Camera: Remidio Fundus on Phone: 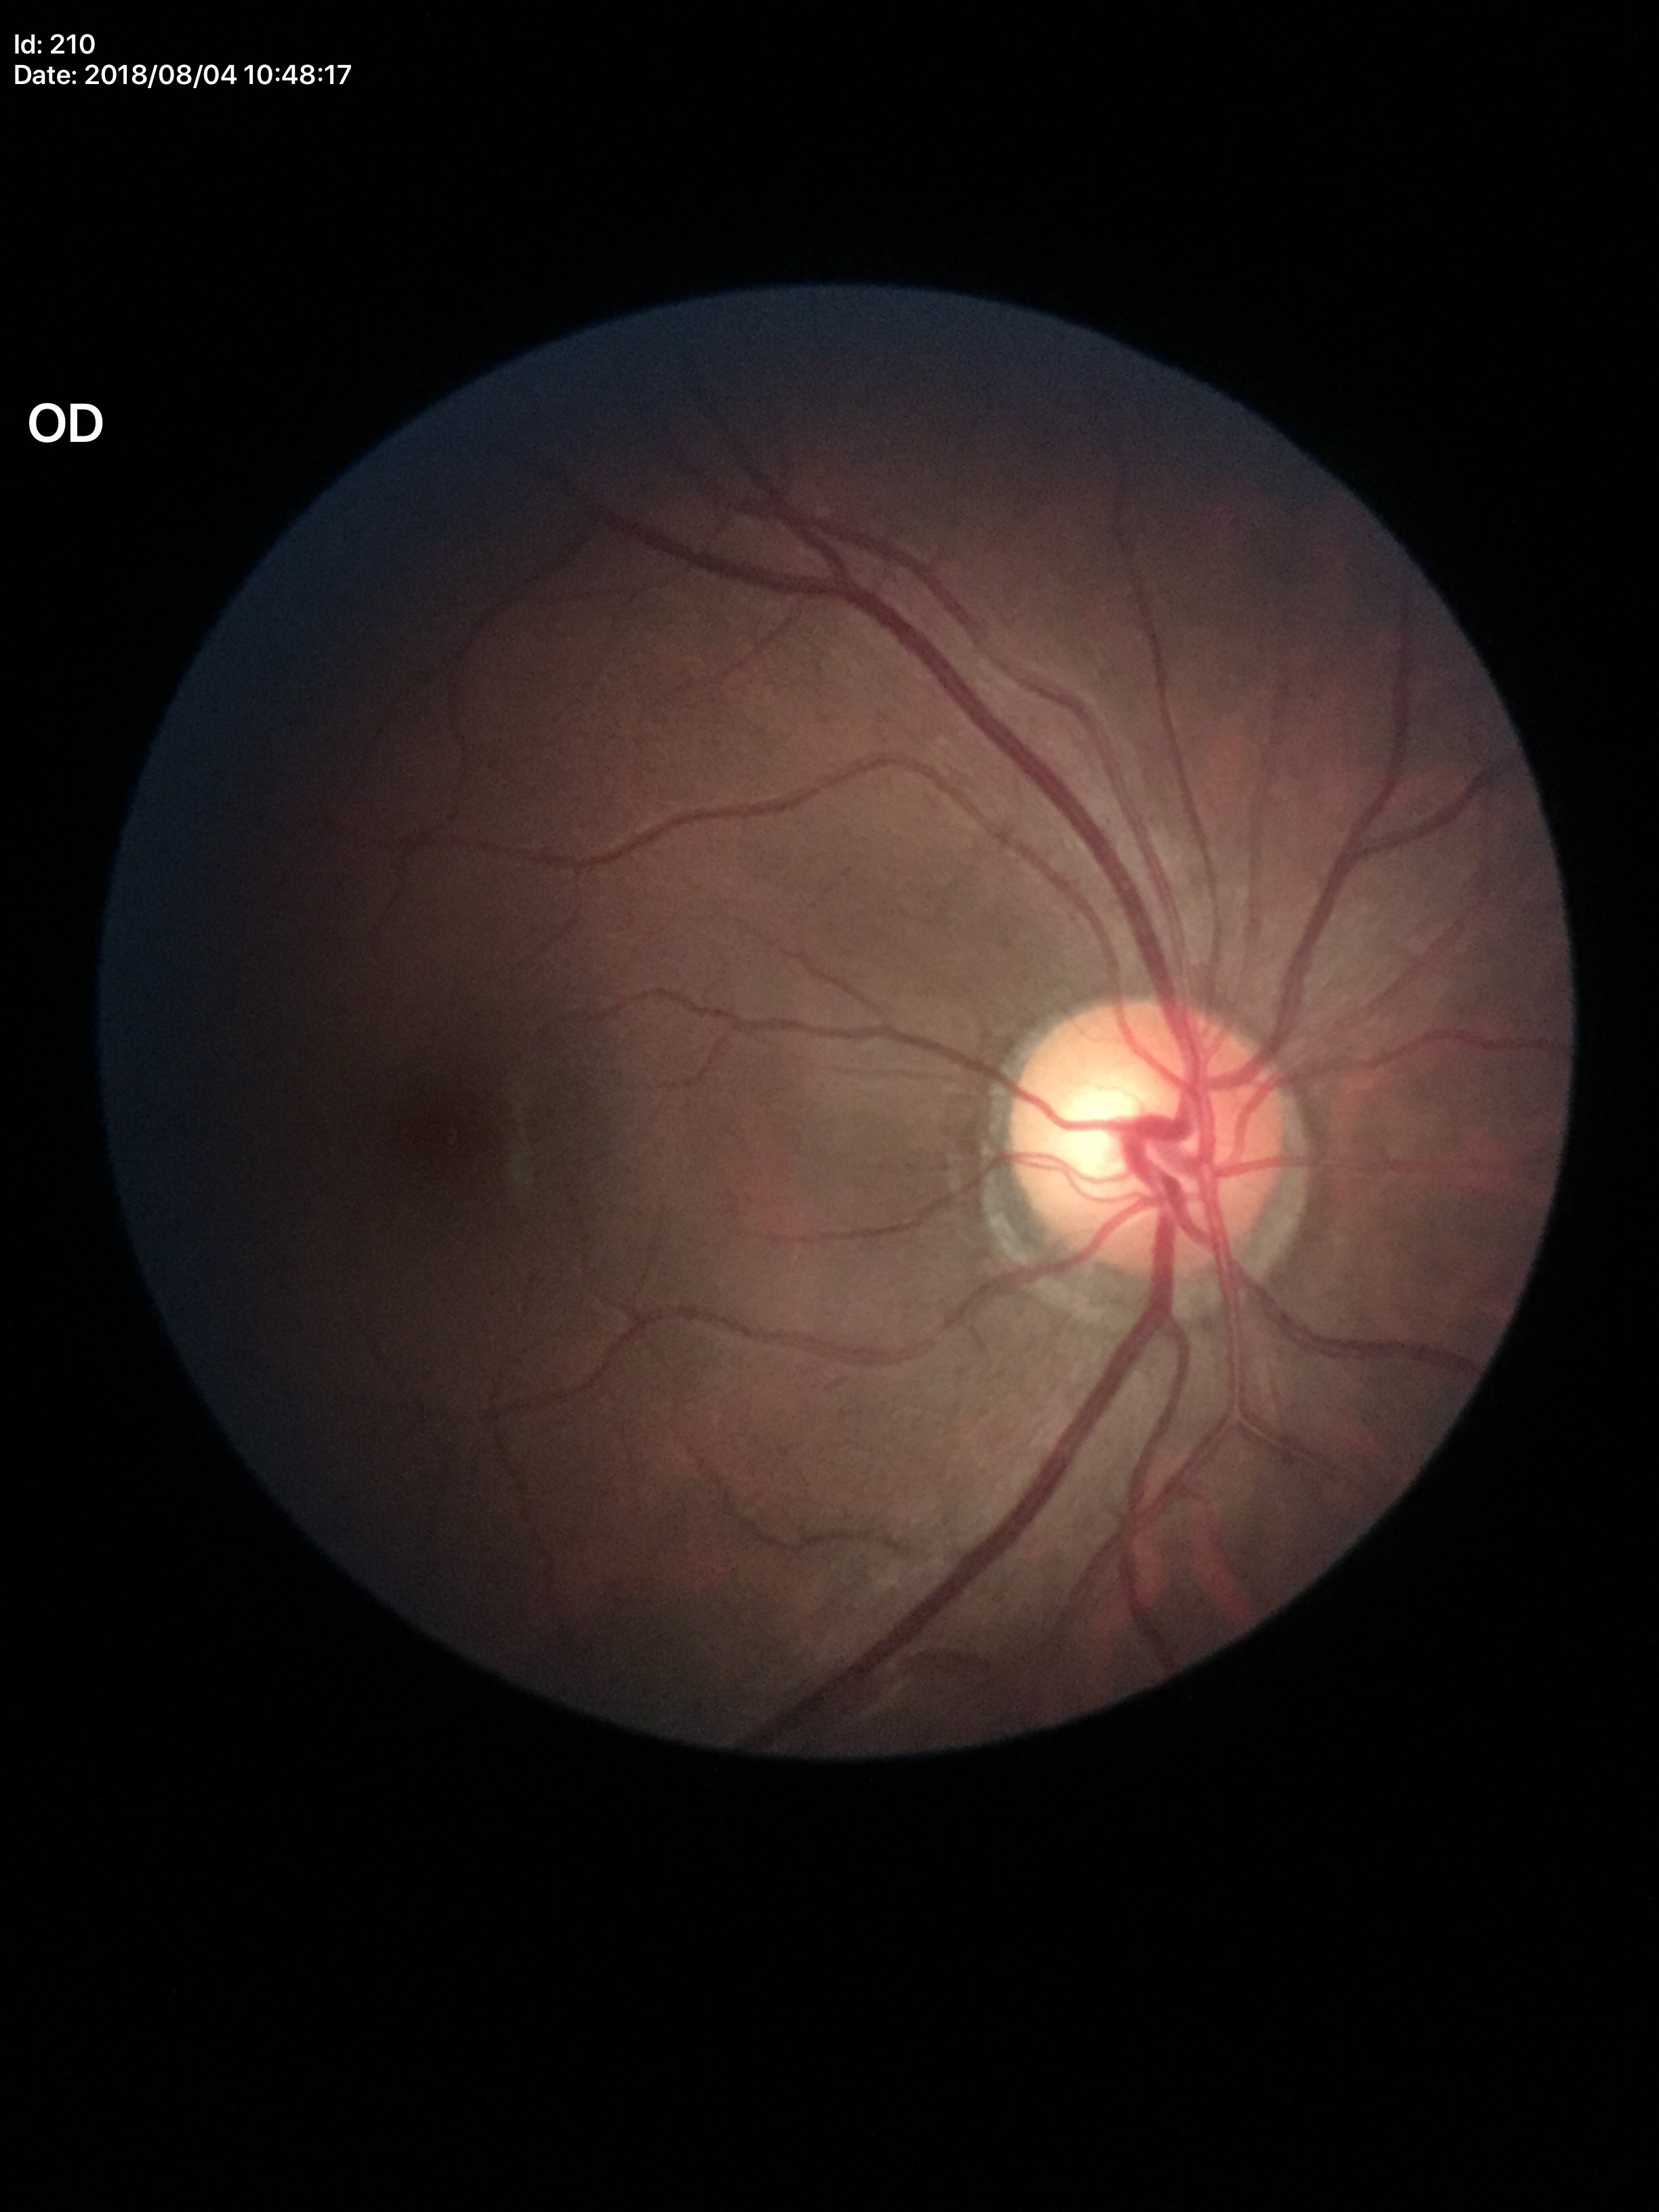
Glaucoma screening impression: not suspect. Vertical cup-disc ratio (VCDR) is 0.60. Horizontal cup-disc ratio (HCDR): 0.59.